Camera: Phoenix ICON (100° FOV); wide-field contact fundus photograph of an infant:
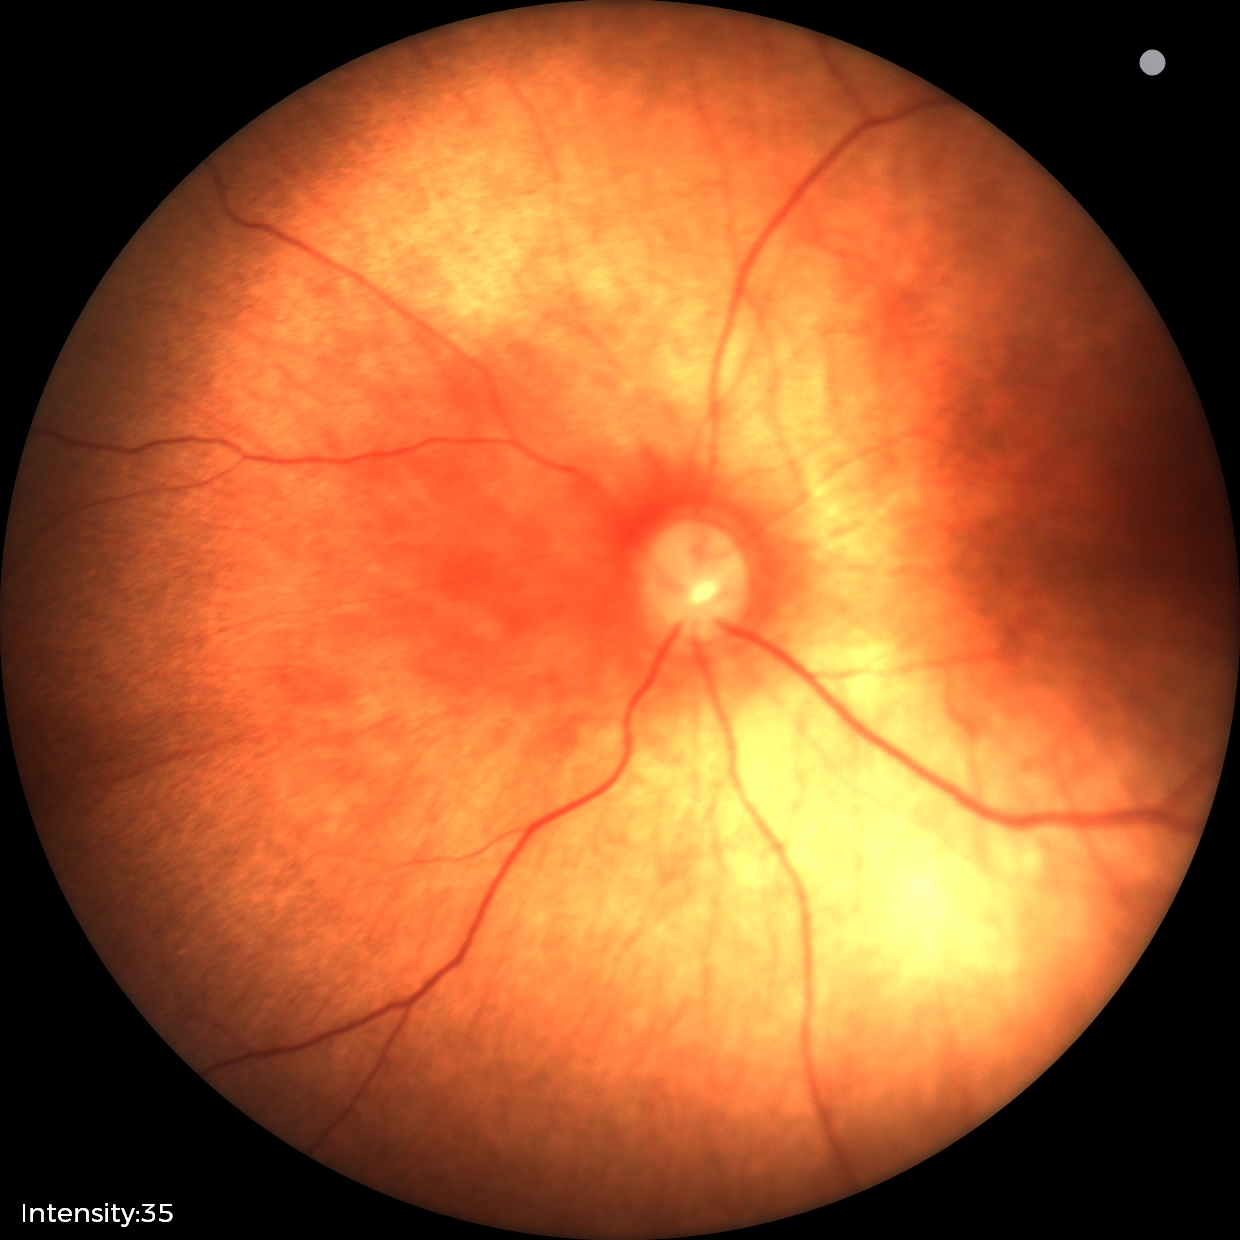

Normal screening examination.